1240 by 1240 pixels · pediatric retinal photograph (wide-field) · acquired on the Phoenix ICON — 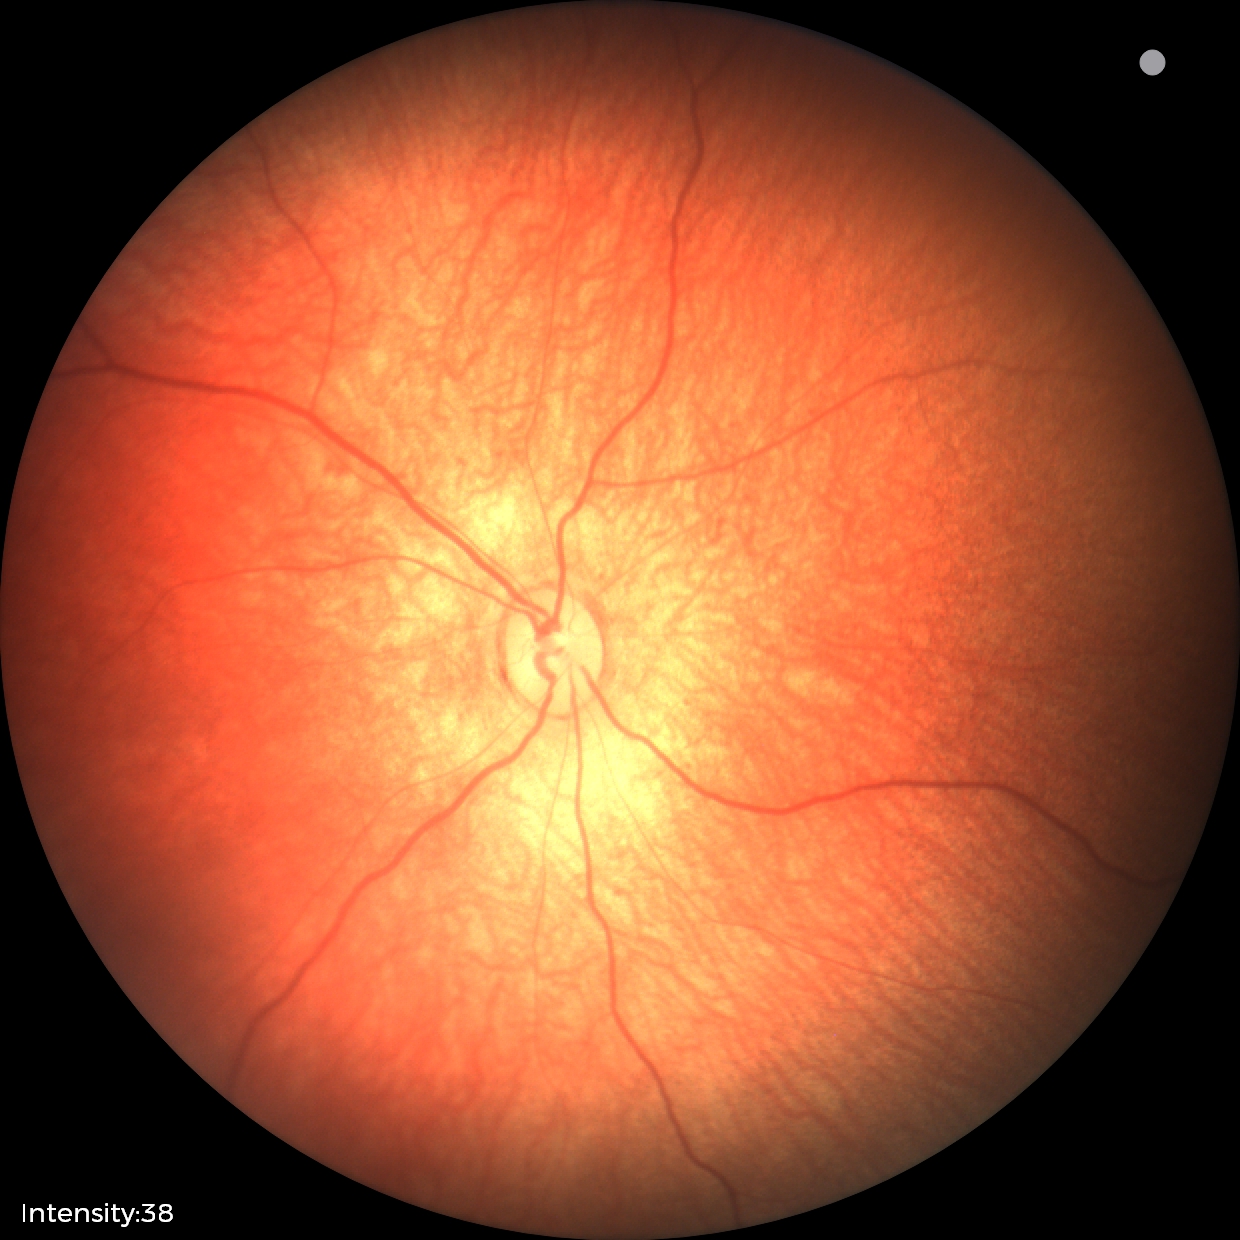

No retinal pathology identified on screening.